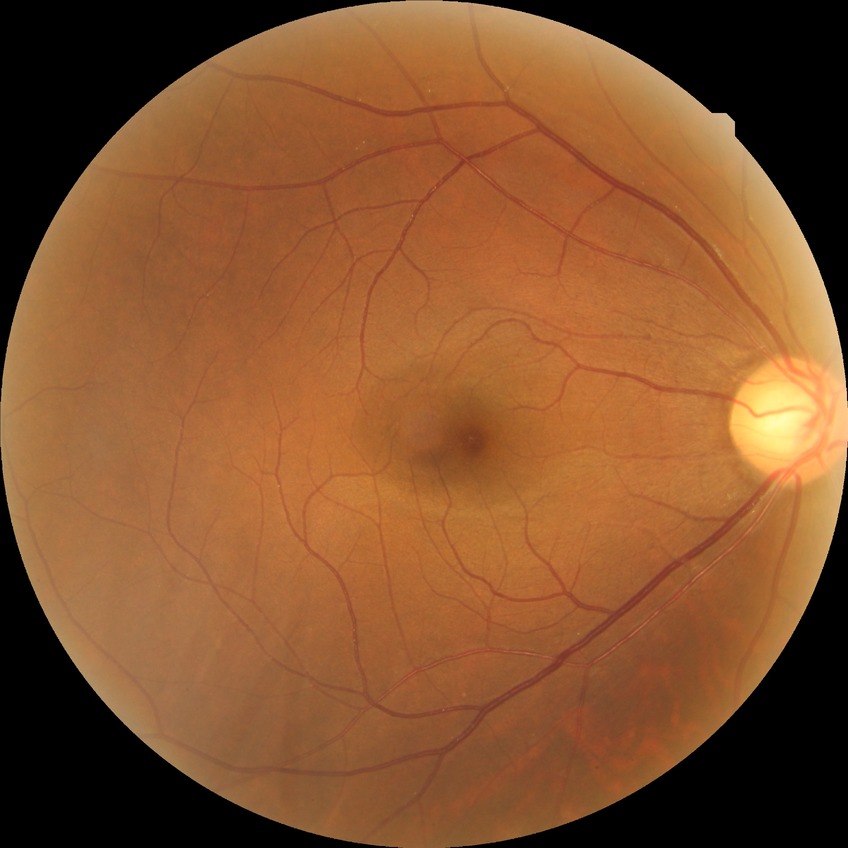 diabetic retinopathy (DR)=no diabetic retinopathy (NDR).